1240 x 1240 pixels. Infant wide-field fundus photograph — 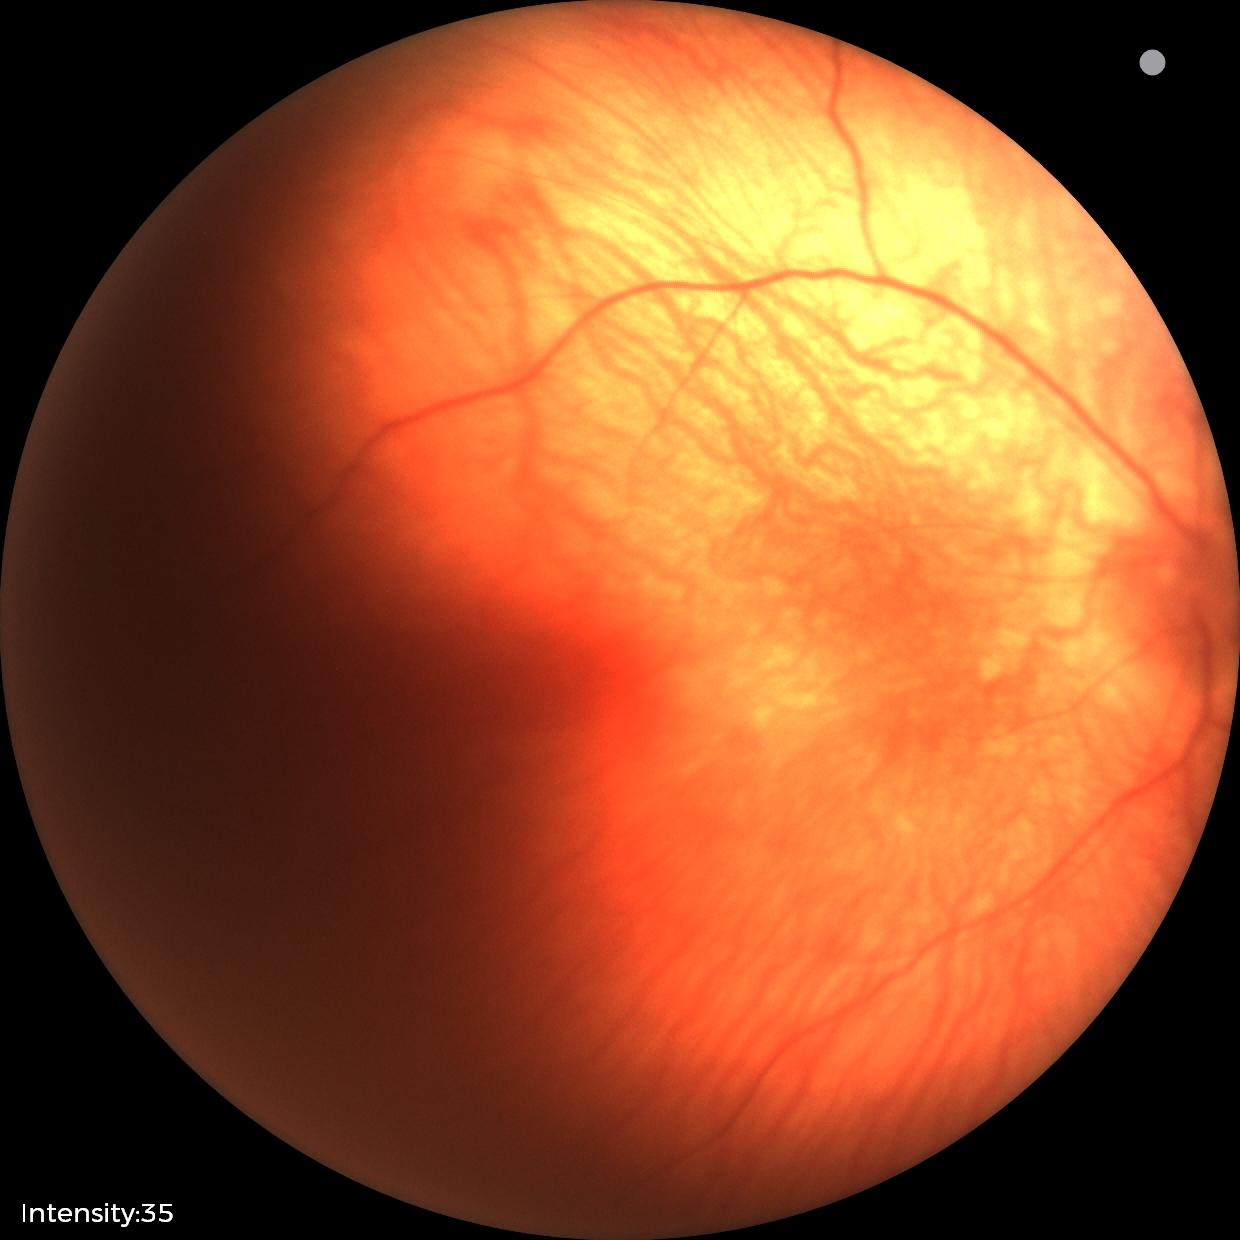
Screening: normal retinal appearance.